Diabetic retinopathy graded by the modified Davis classification: 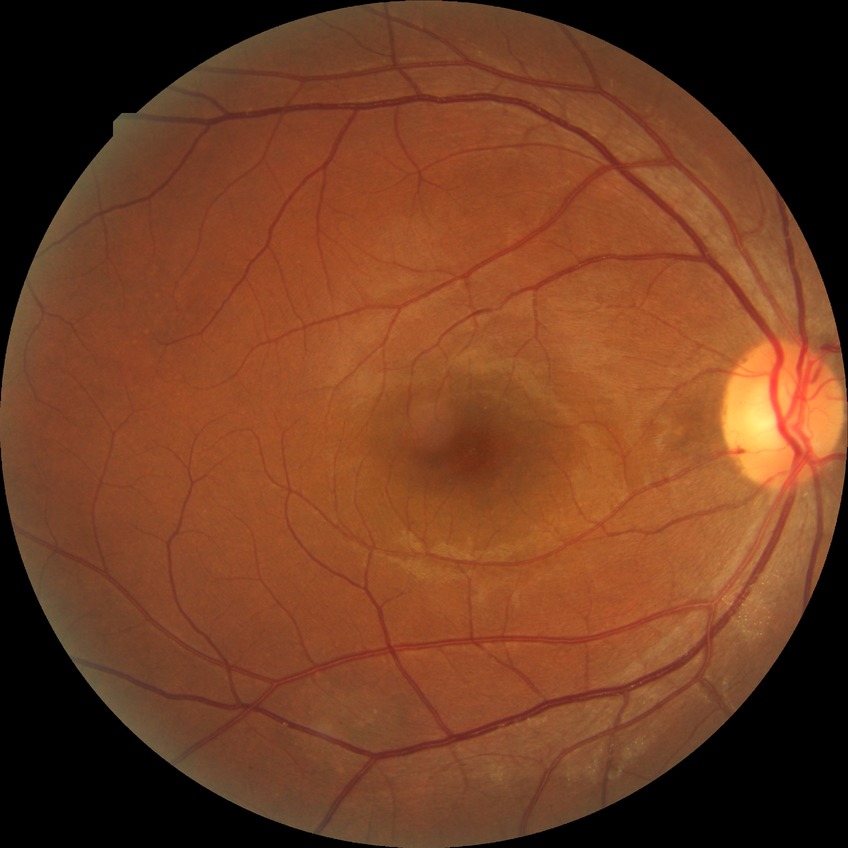

Retinopathy stage: no diabetic retinopathy.